Captured with the Clarity RetCam 3 (130° field of view). Wide-field contact fundus photograph of an infant:
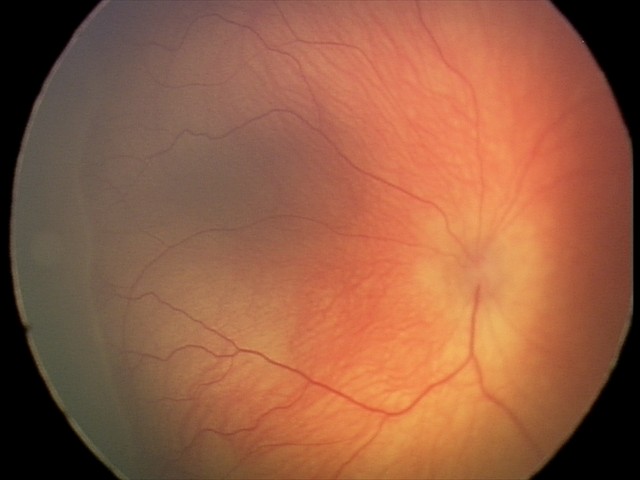 Q: Is plus disease present?
A: no plus disease
Q: What is the screening diagnosis?
A: retinopathy of prematurity stage 2